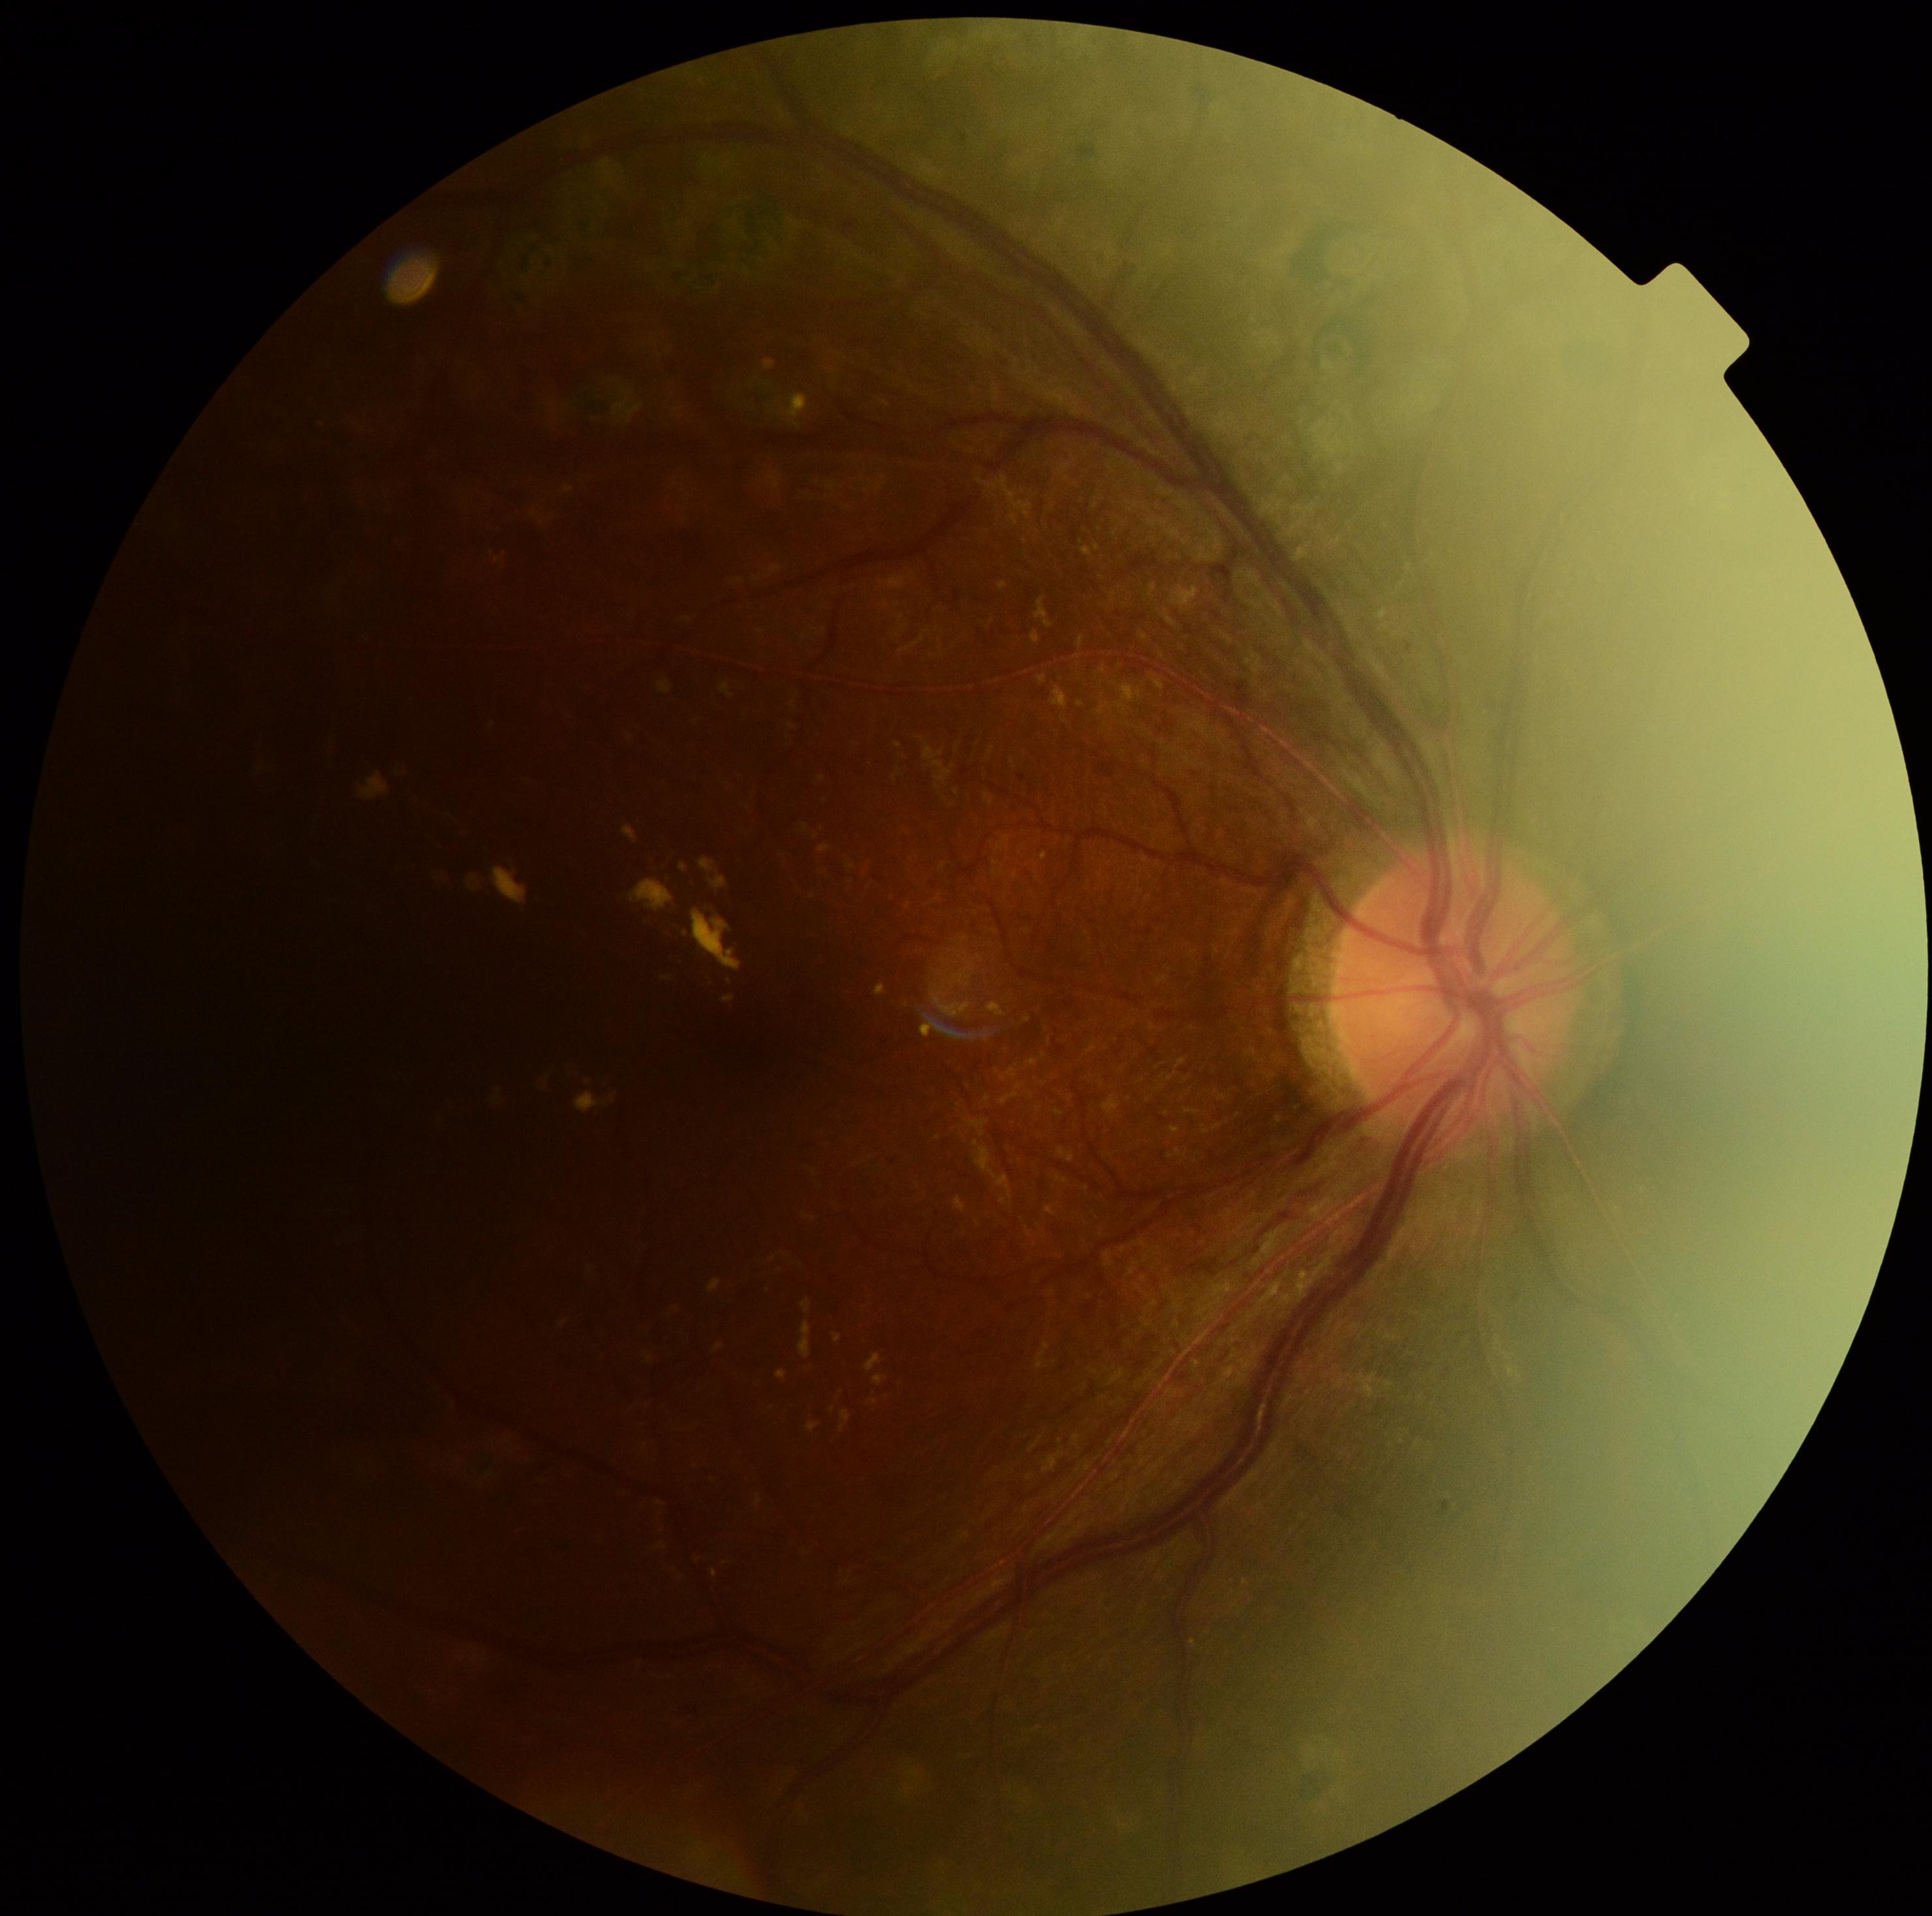

DR: grade 2 (moderate NPDR).